Autorefraction: +2 -1 x 80; 62-year-old patient; male patient; central corneal thickness: 558 µm; axial length: 22.72 mm.
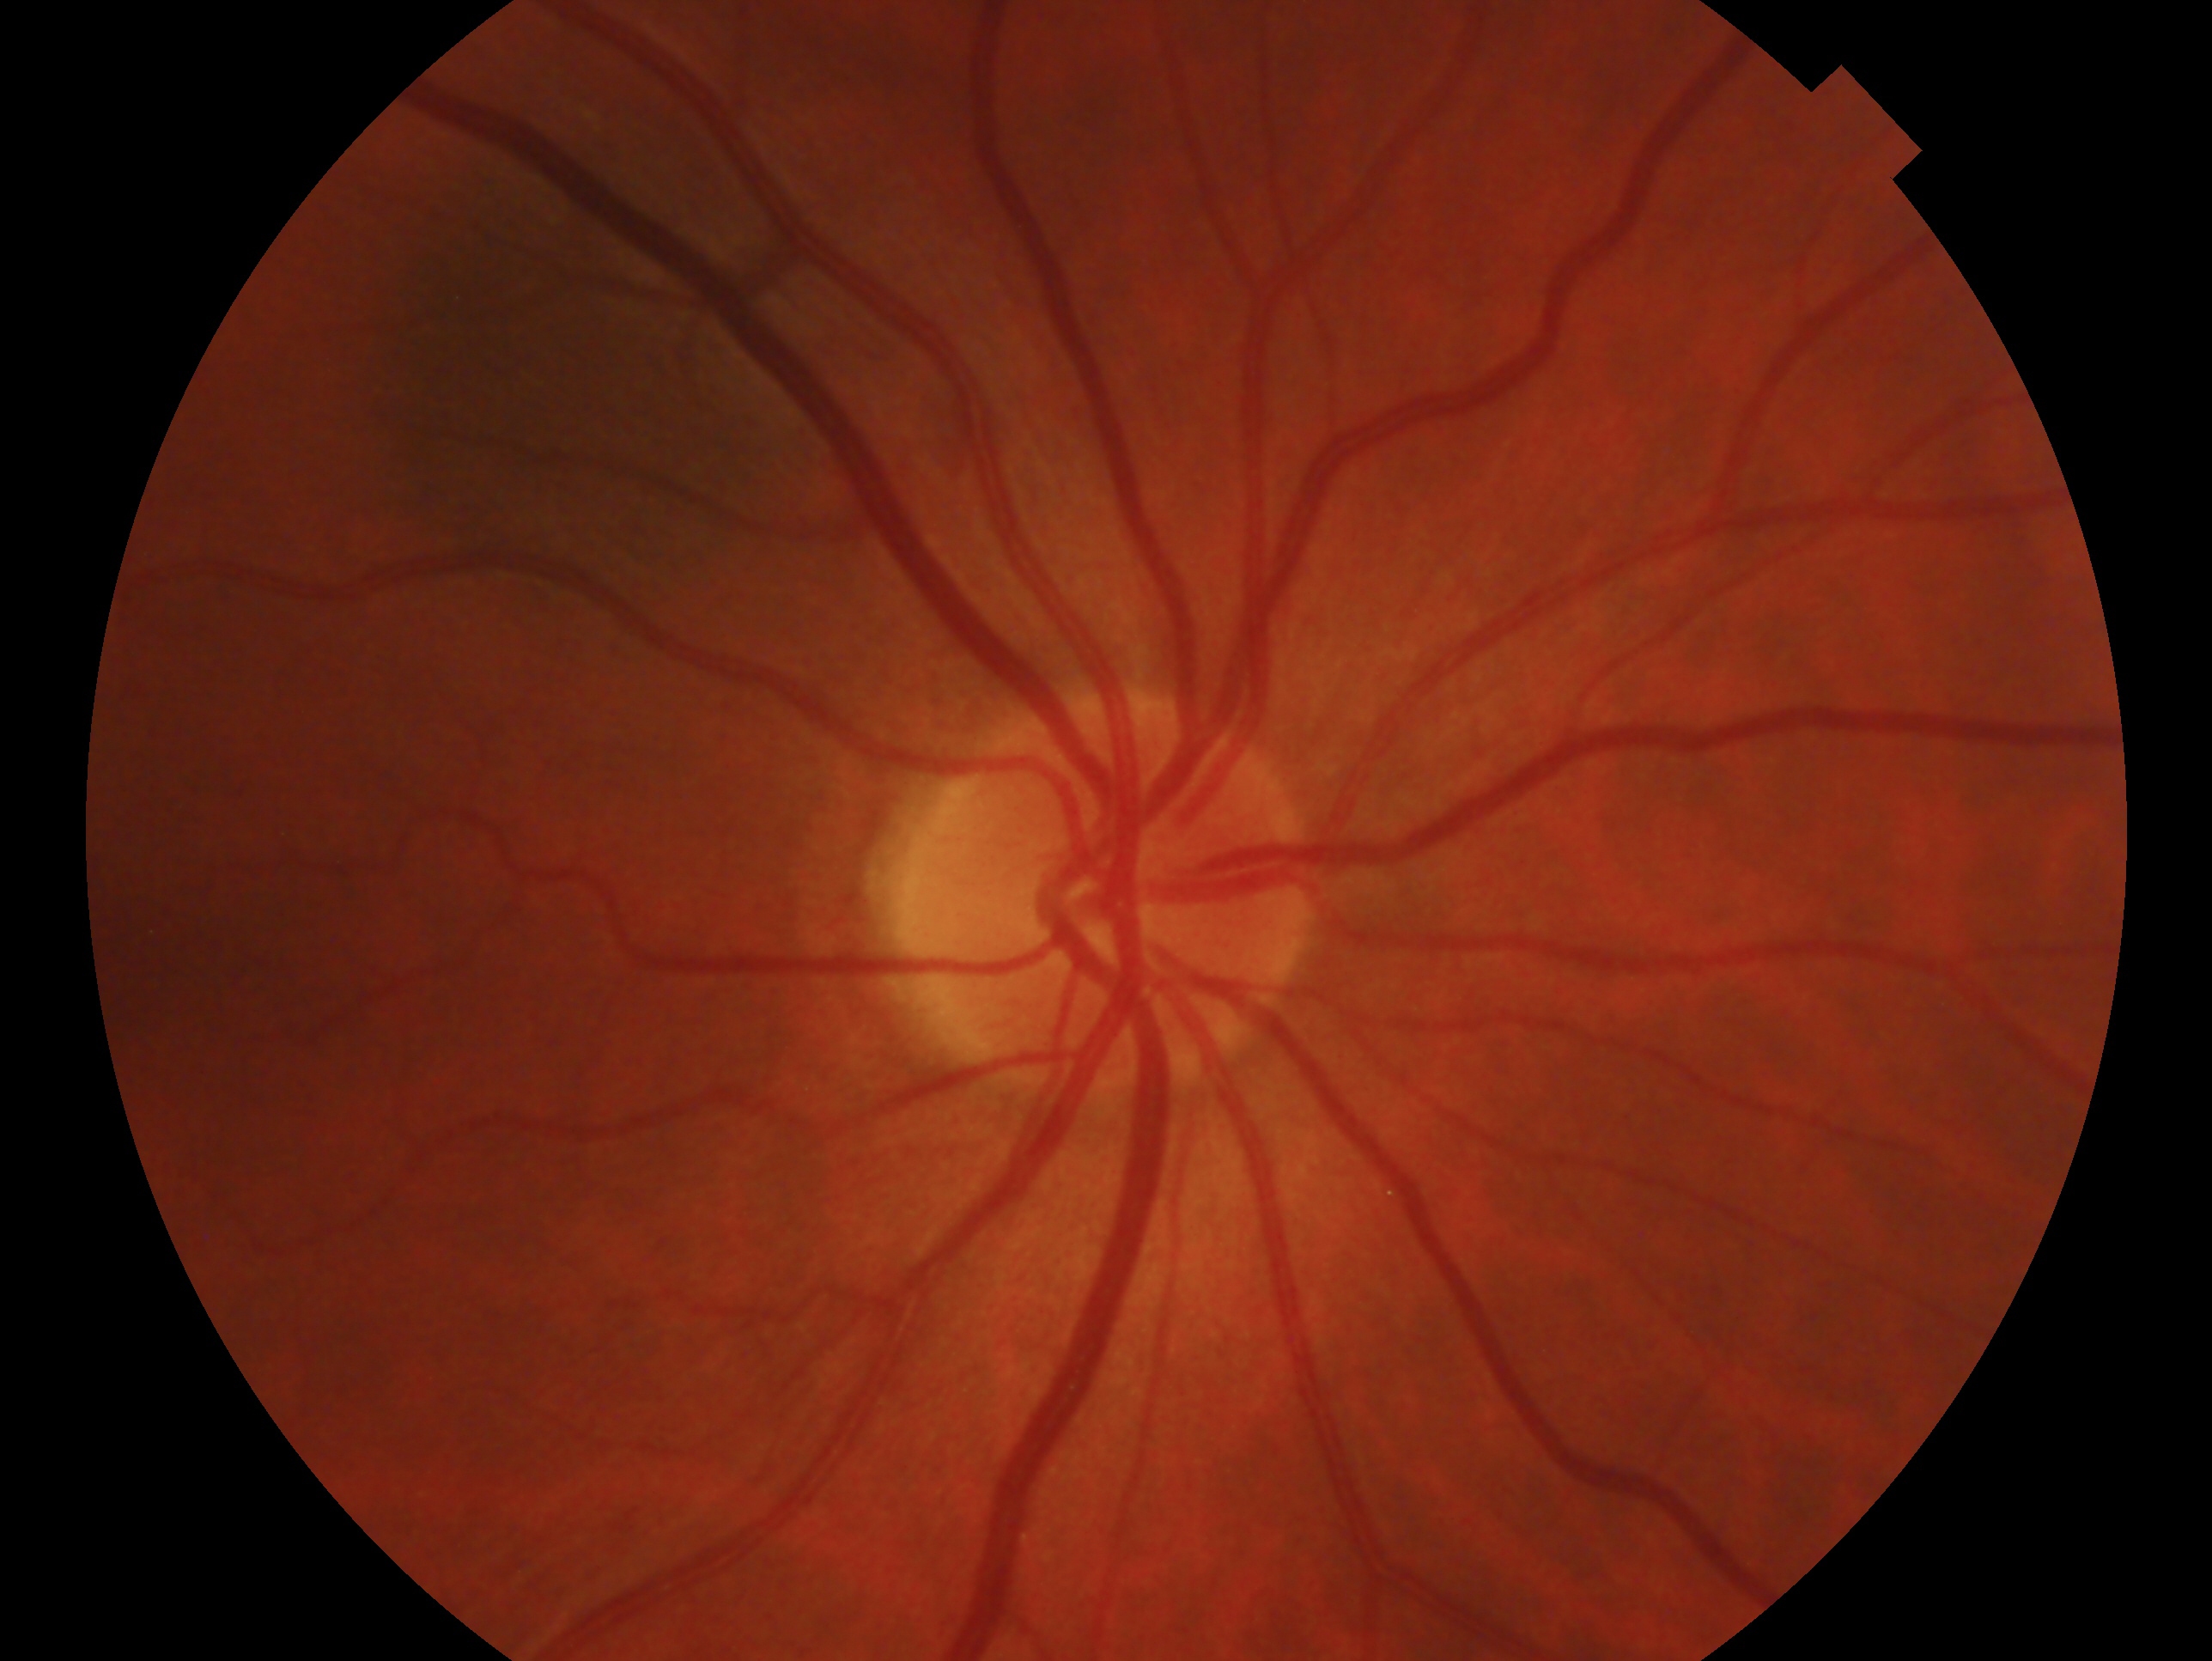 {
  "glaucoma_dx": "no glaucoma",
  "eye": "OD"
}